2212 by 1659 pixels.
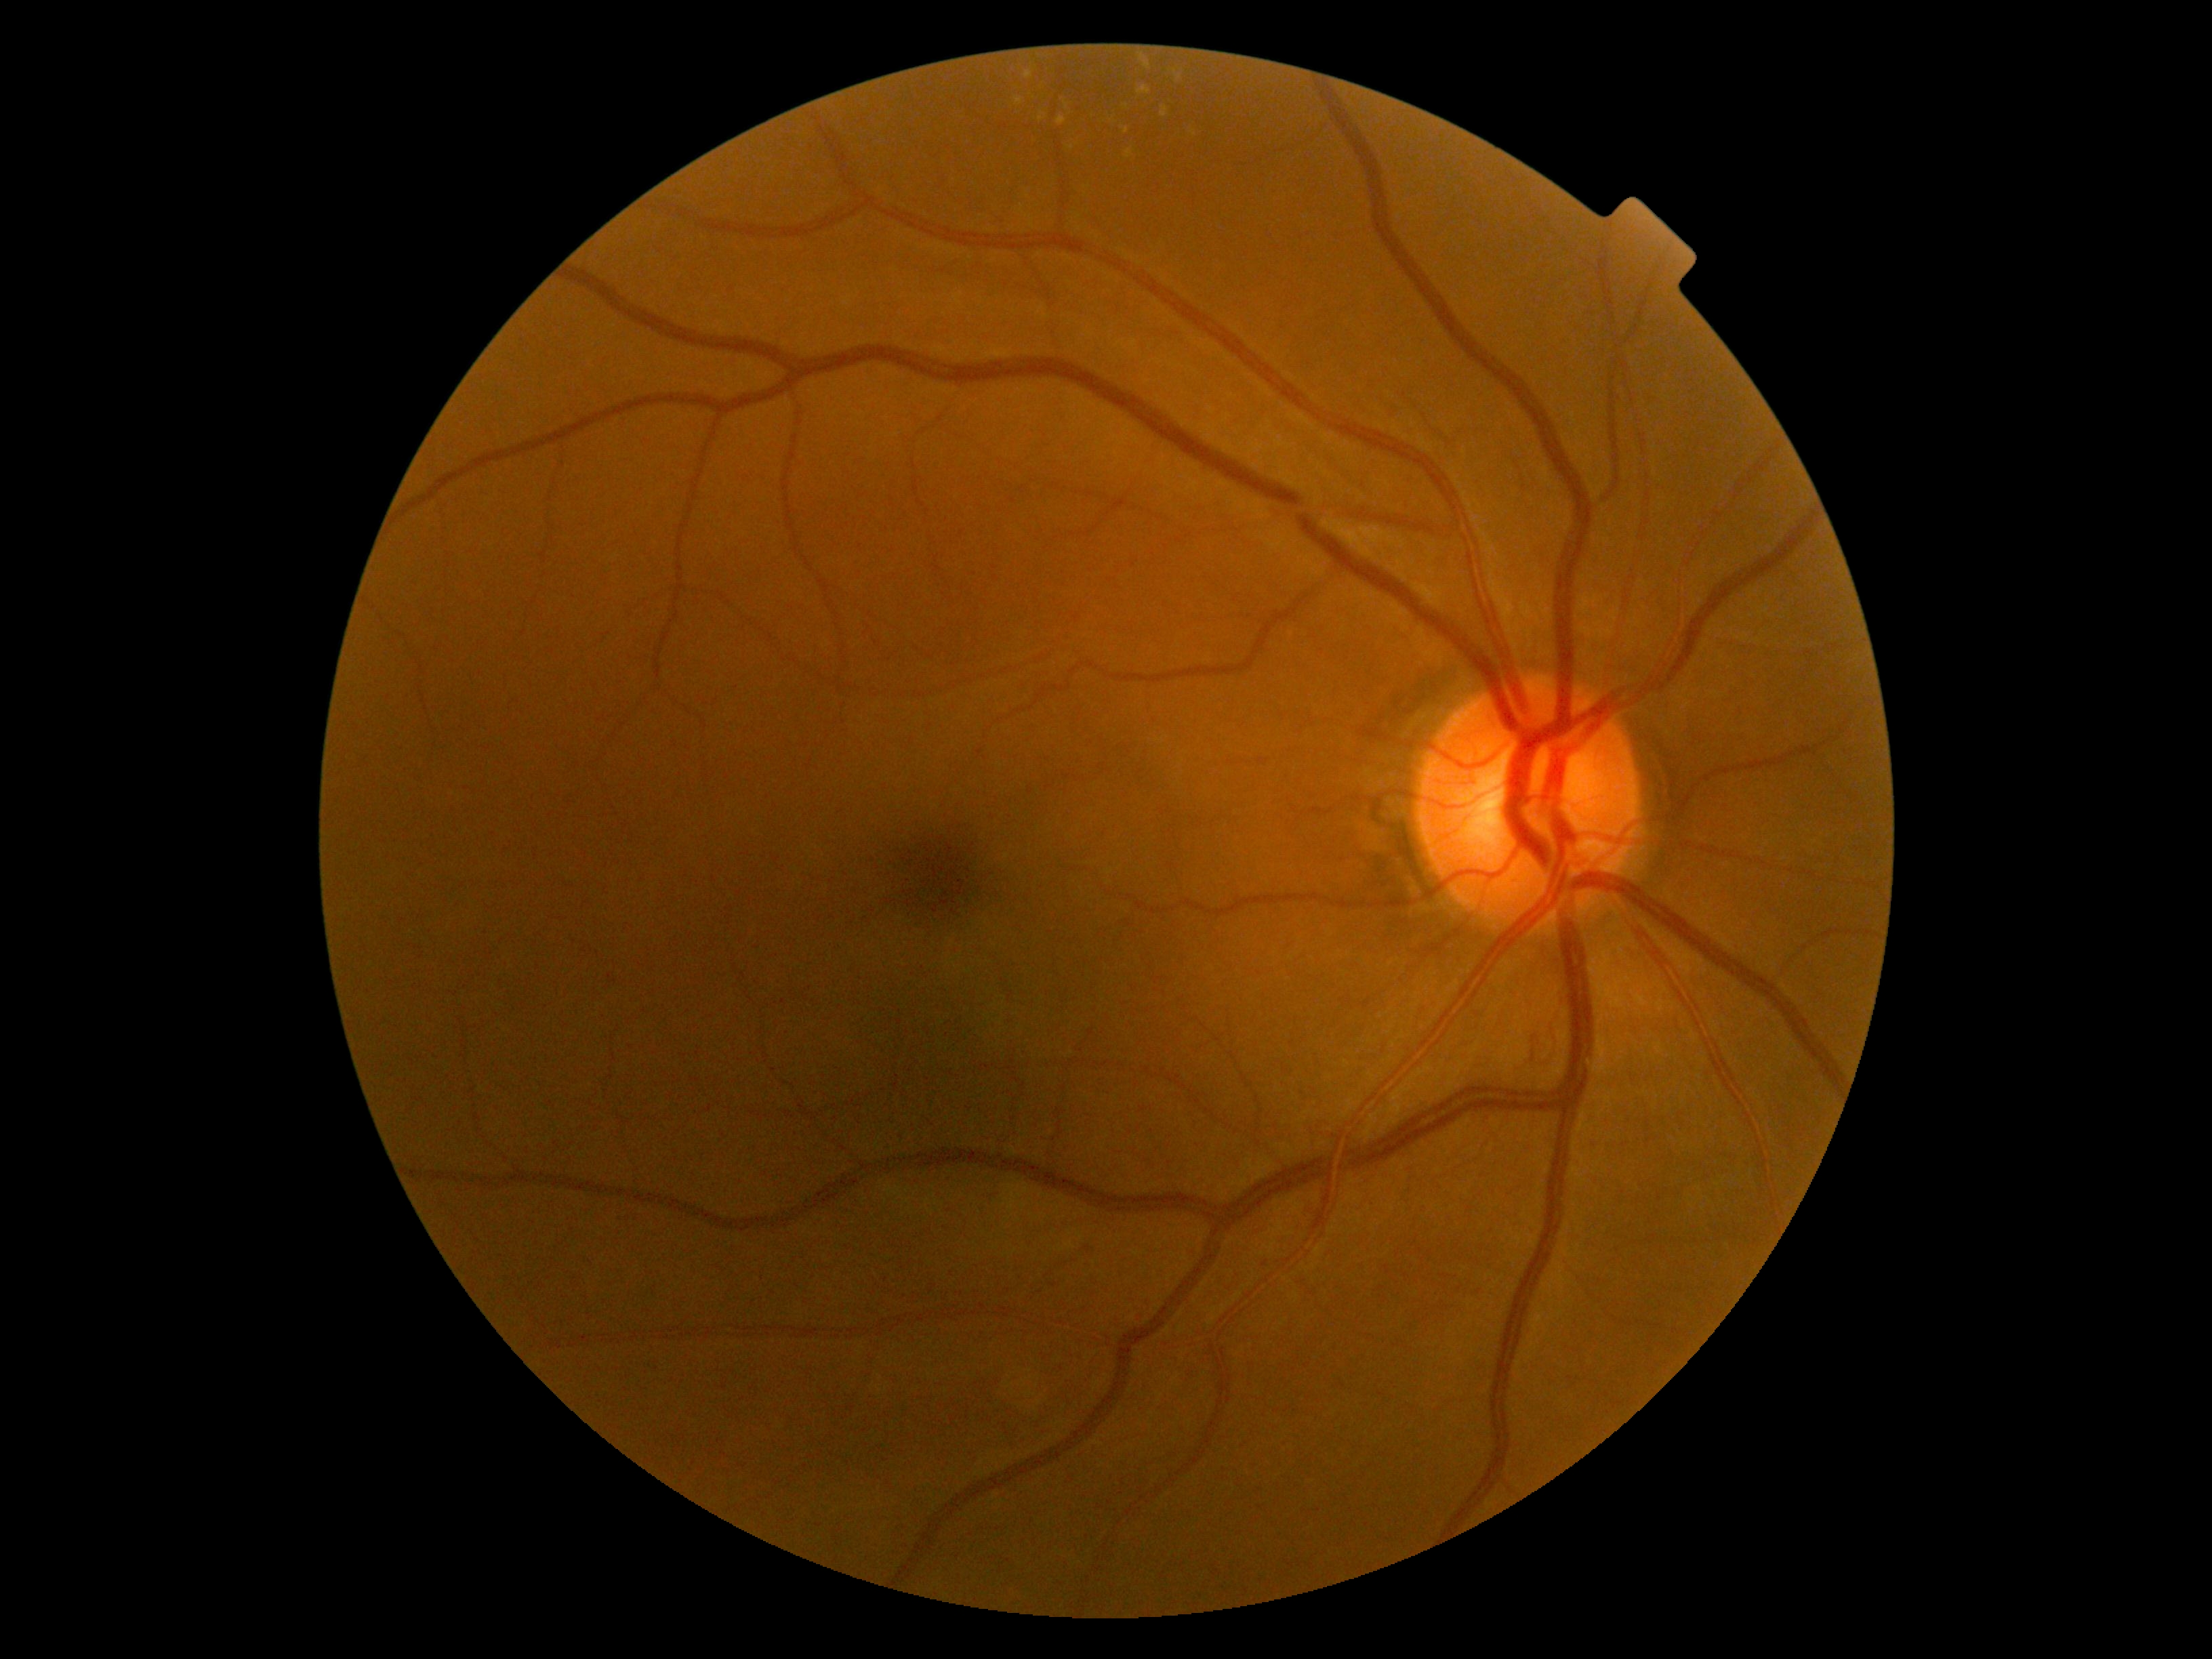
Annotations:
• diabetic retinopathy grade — moderate non-proliferative diabetic retinopathy (2)